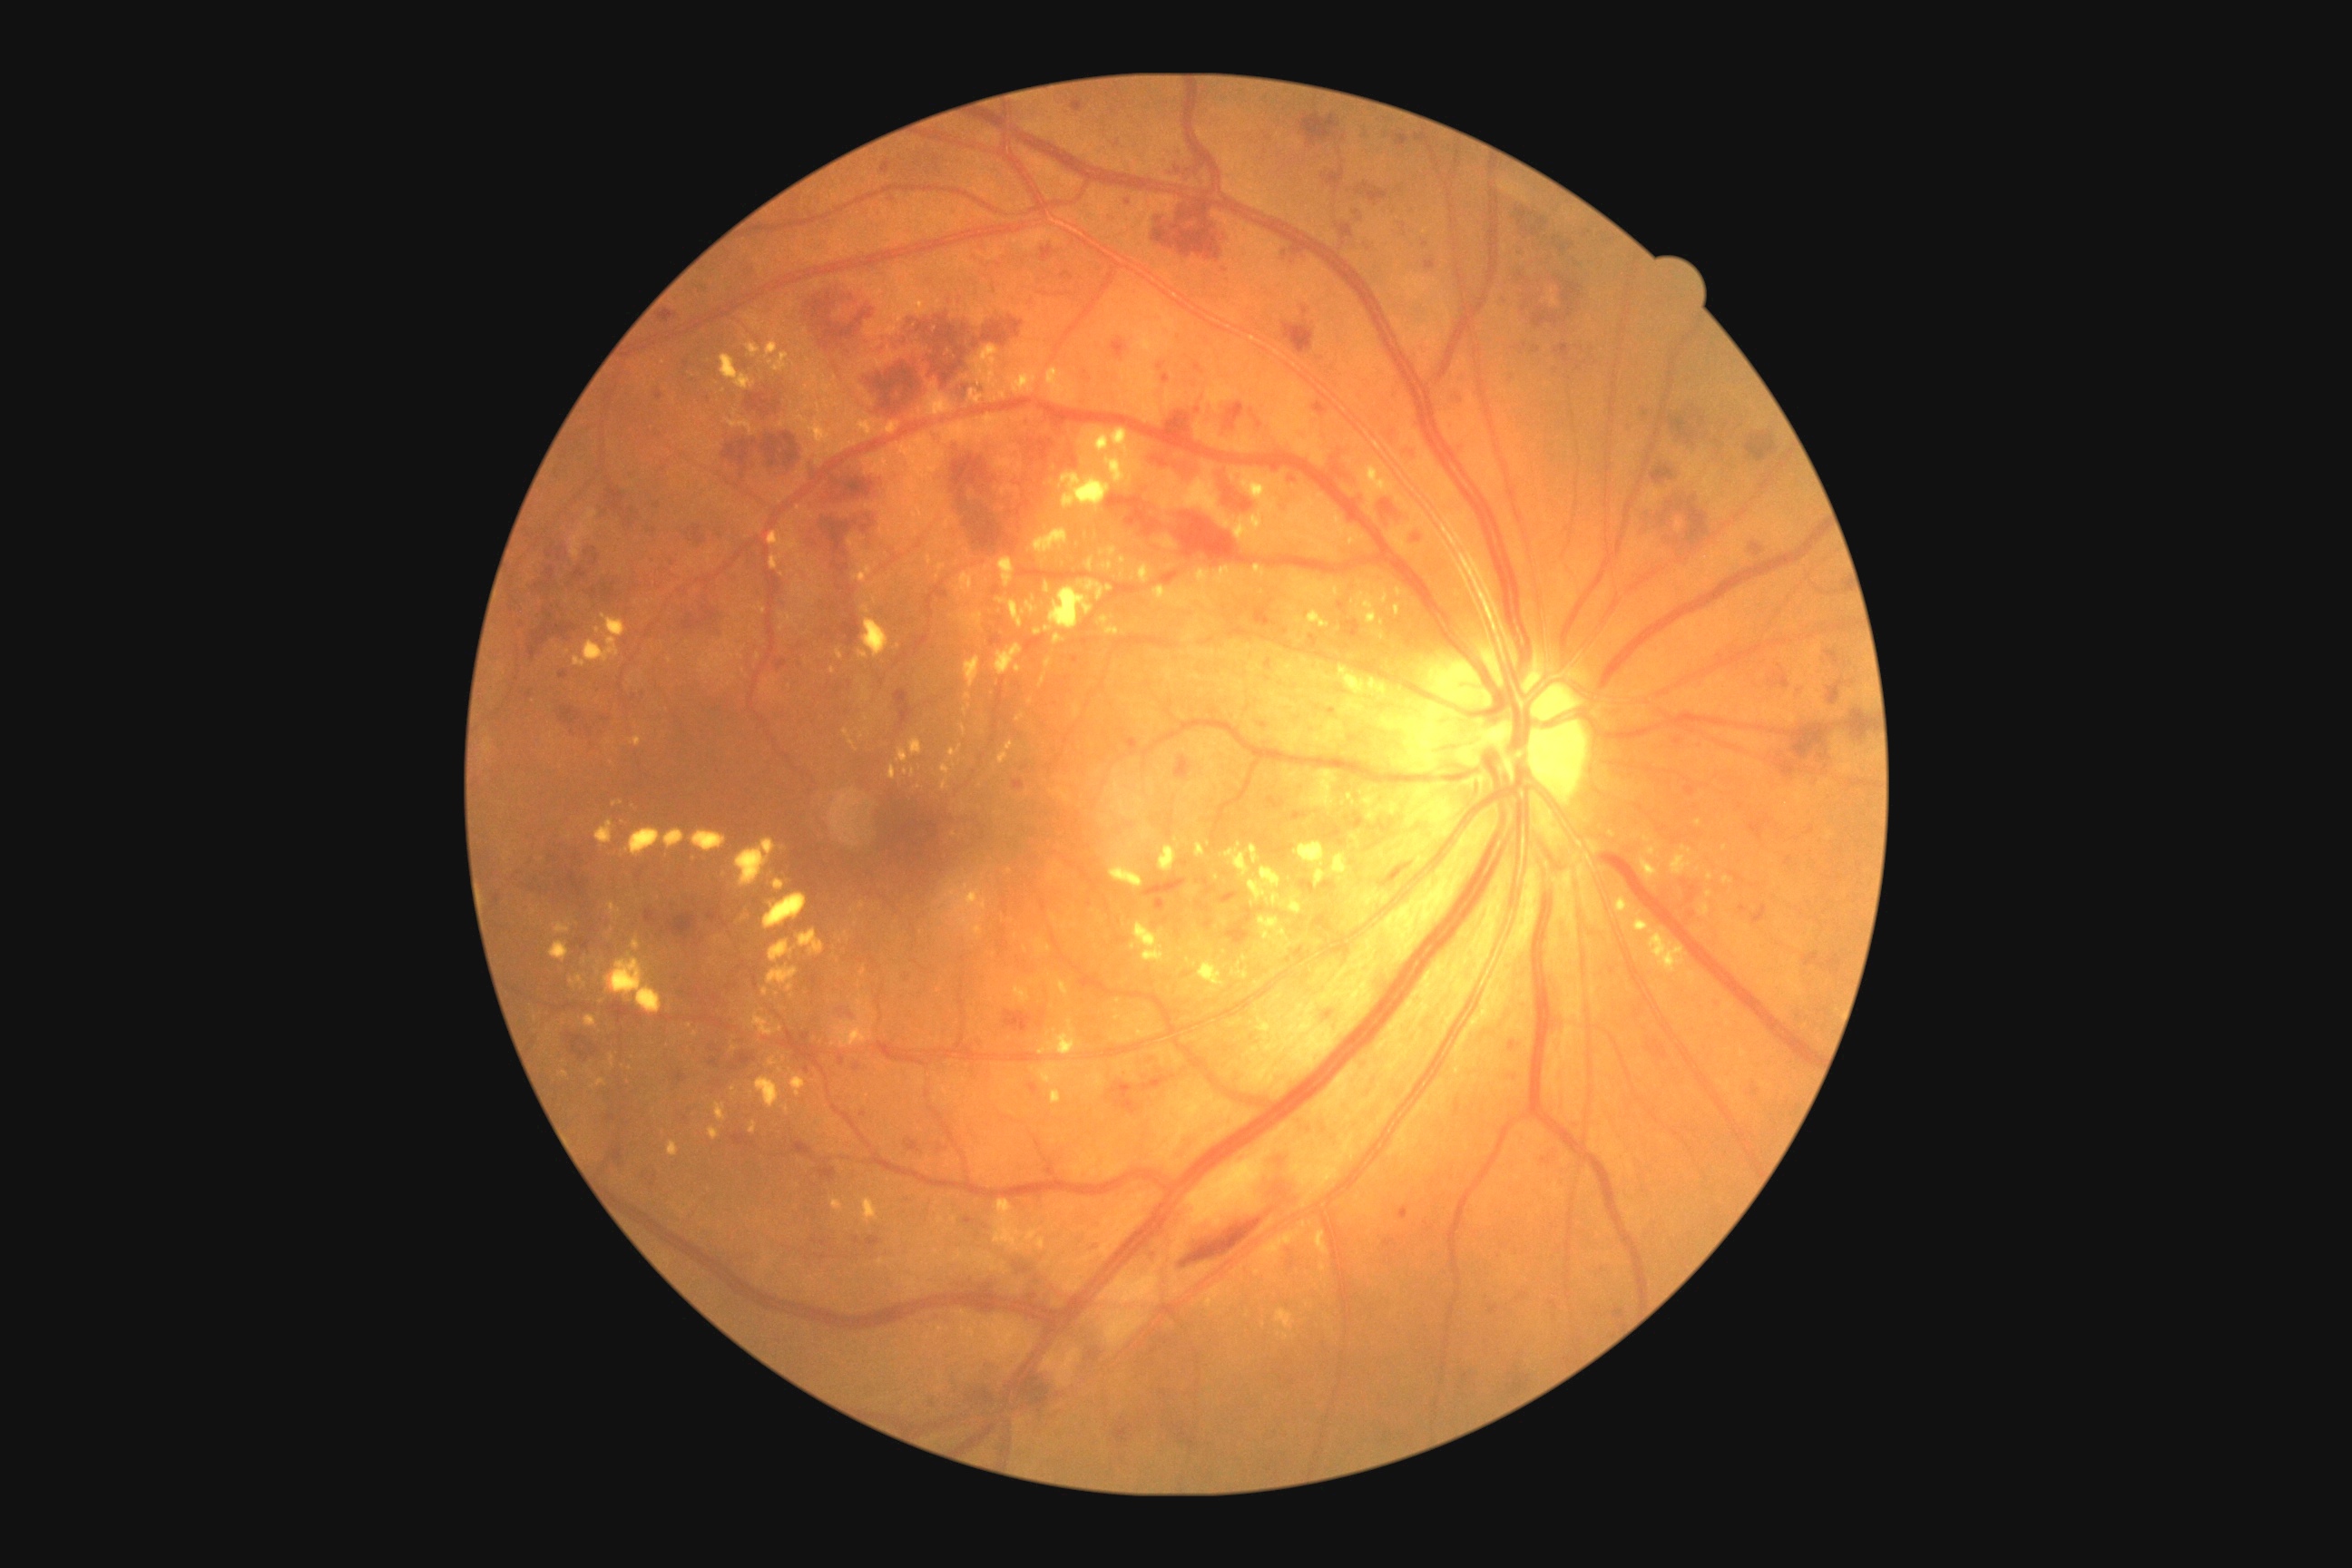

DR severity: severe NPDR (grade 3)
Selected lesions:
HEs (partial): BBox(1226, 906, 1253, 946) | BBox(1516, 208, 1549, 237) | BBox(1847, 710, 1872, 741) | BBox(1224, 402, 1244, 431) | BBox(1291, 246, 1298, 262) | BBox(573, 567, 589, 580) | BBox(1014, 1366, 1050, 1415) | BBox(721, 433, 799, 480) | BBox(832, 562, 850, 576) | BBox(583, 549, 596, 556) | BBox(1651, 464, 1674, 484) | BBox(1324, 1012, 1333, 1019) | BBox(534, 567, 556, 591) | BBox(1380, 500, 1398, 520) | BBox(1271, 1182, 1289, 1200) | BBox(952, 455, 995, 513) | BBox(674, 607, 720, 638)
Smaller HEs around pt(1033, 461) | pt(1461, 374)
EXs (partial): BBox(1086, 558, 1093, 571) | BBox(710, 957, 714, 965) | BBox(709, 1128, 720, 1141) | BBox(1313, 872, 1335, 890) | BBox(1044, 583, 1050, 594) | BBox(925, 382, 954, 418) | BBox(625, 828, 685, 858) | BBox(750, 1122, 756, 1135) | BBox(863, 687, 870, 701) | BBox(999, 556, 1015, 589) | BBox(883, 422, 899, 435) | BBox(767, 966, 798, 992) | BBox(1101, 547, 1117, 558) | BBox(1014, 986, 1030, 1004) | BBox(1086, 429, 1141, 487)
Smaller EXs around pt(534, 914) | pt(735, 413) | pt(573, 982) | pt(863, 556)